Fundus photo.
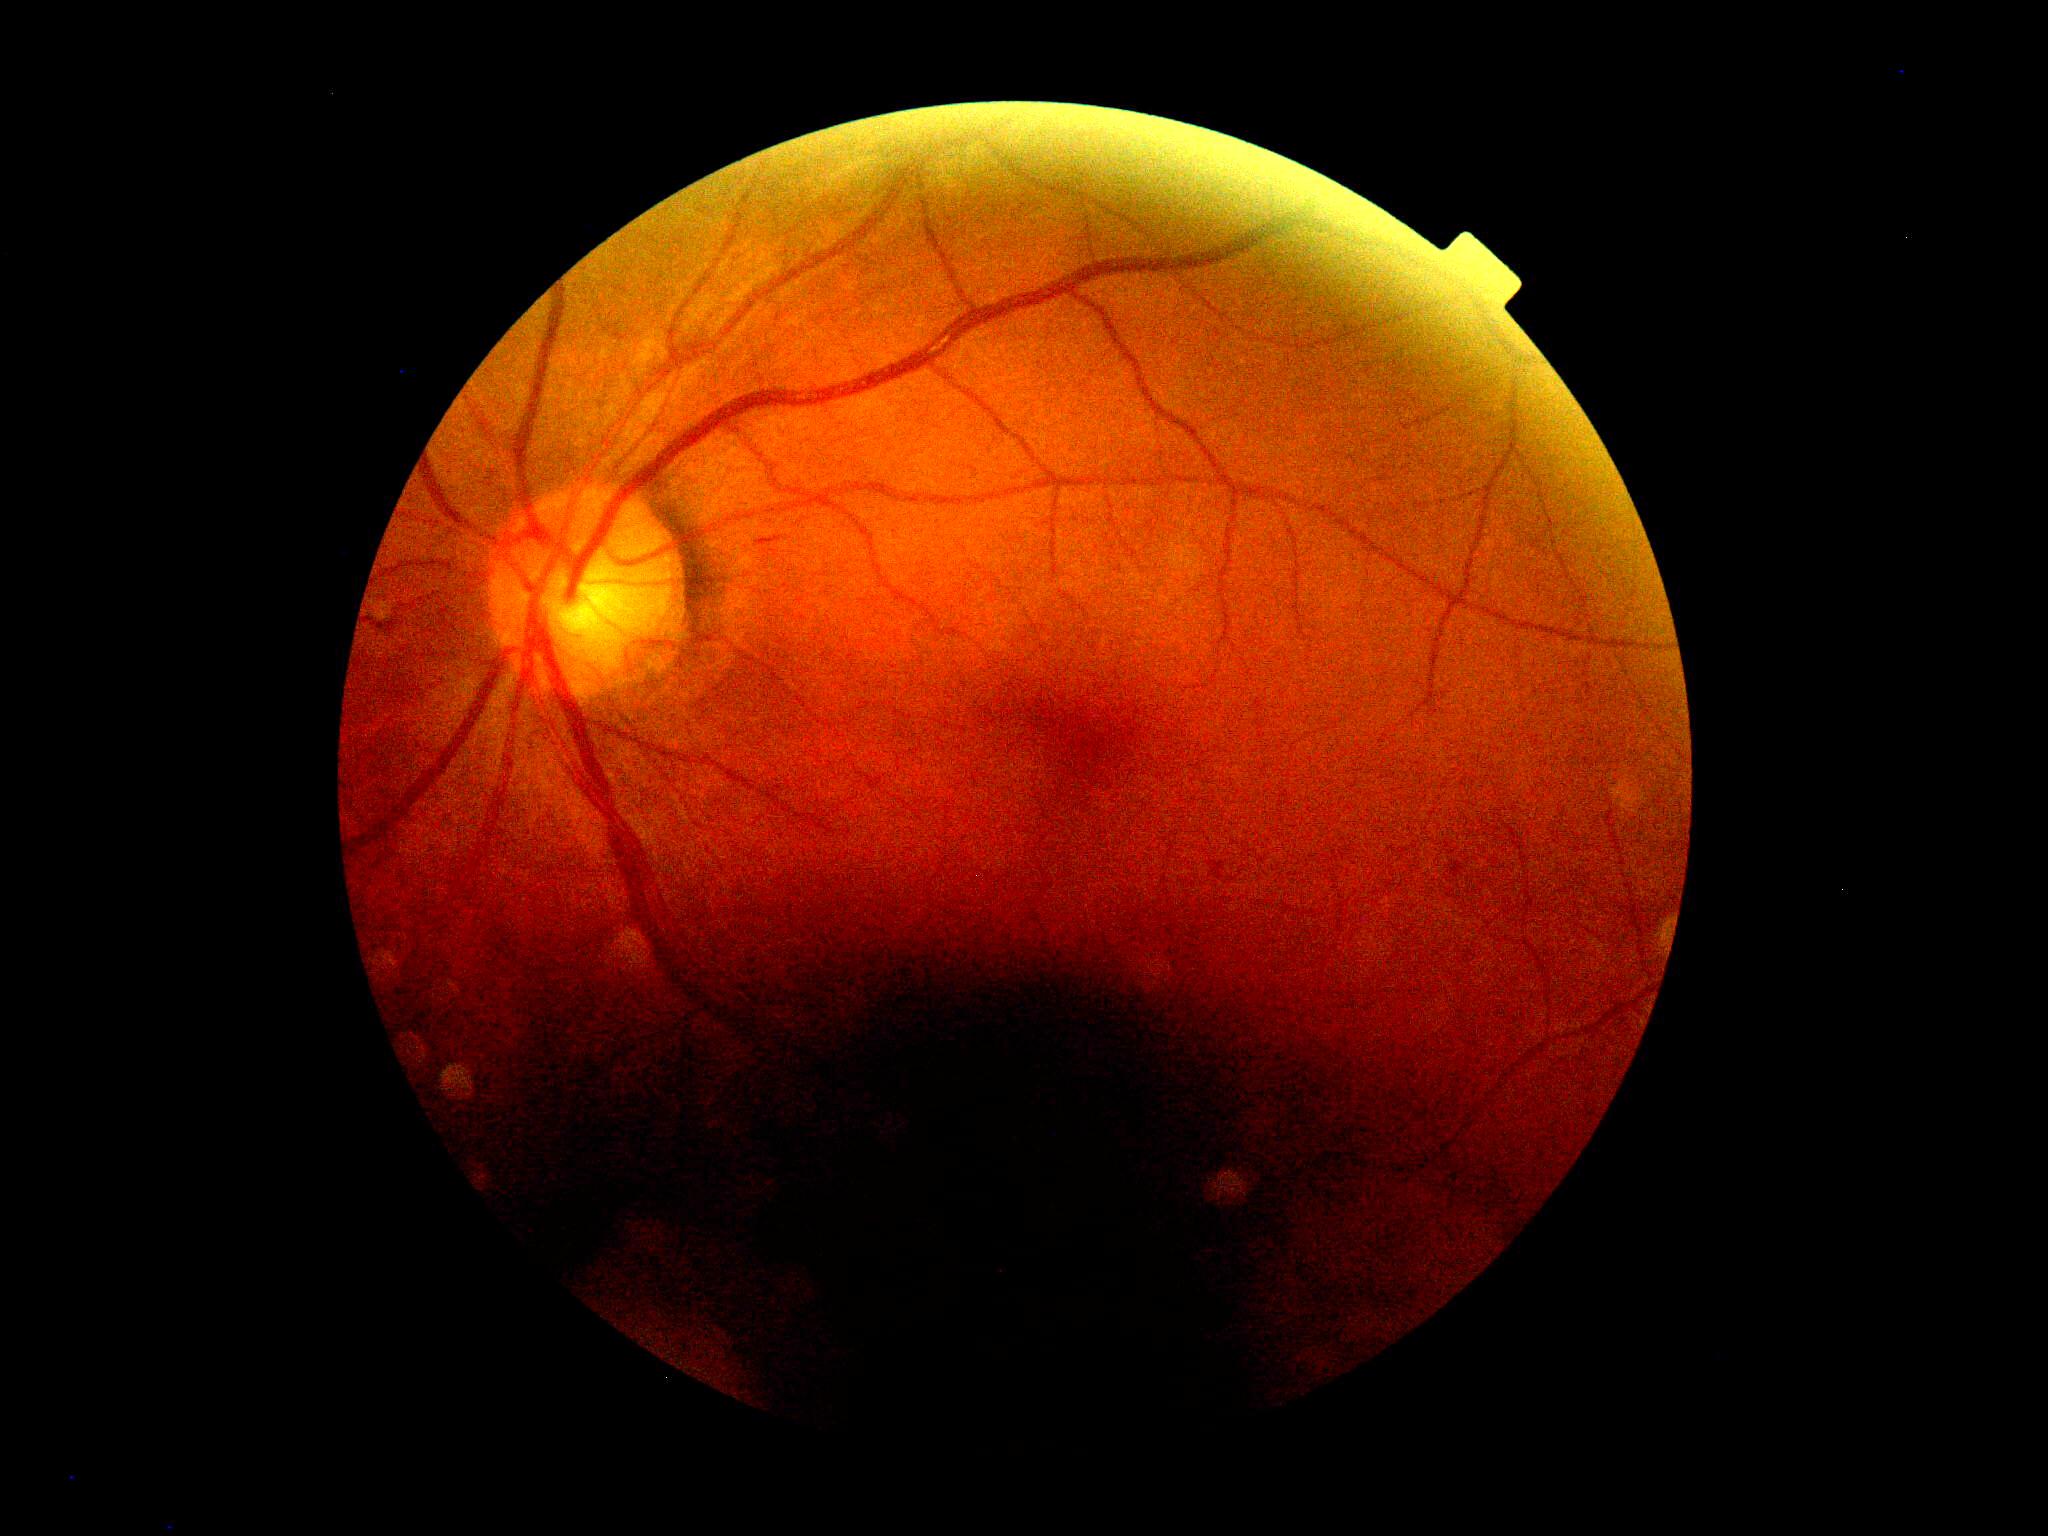

DR stage: grade 2 (moderate NPDR).